Infant wide-field retinal image.
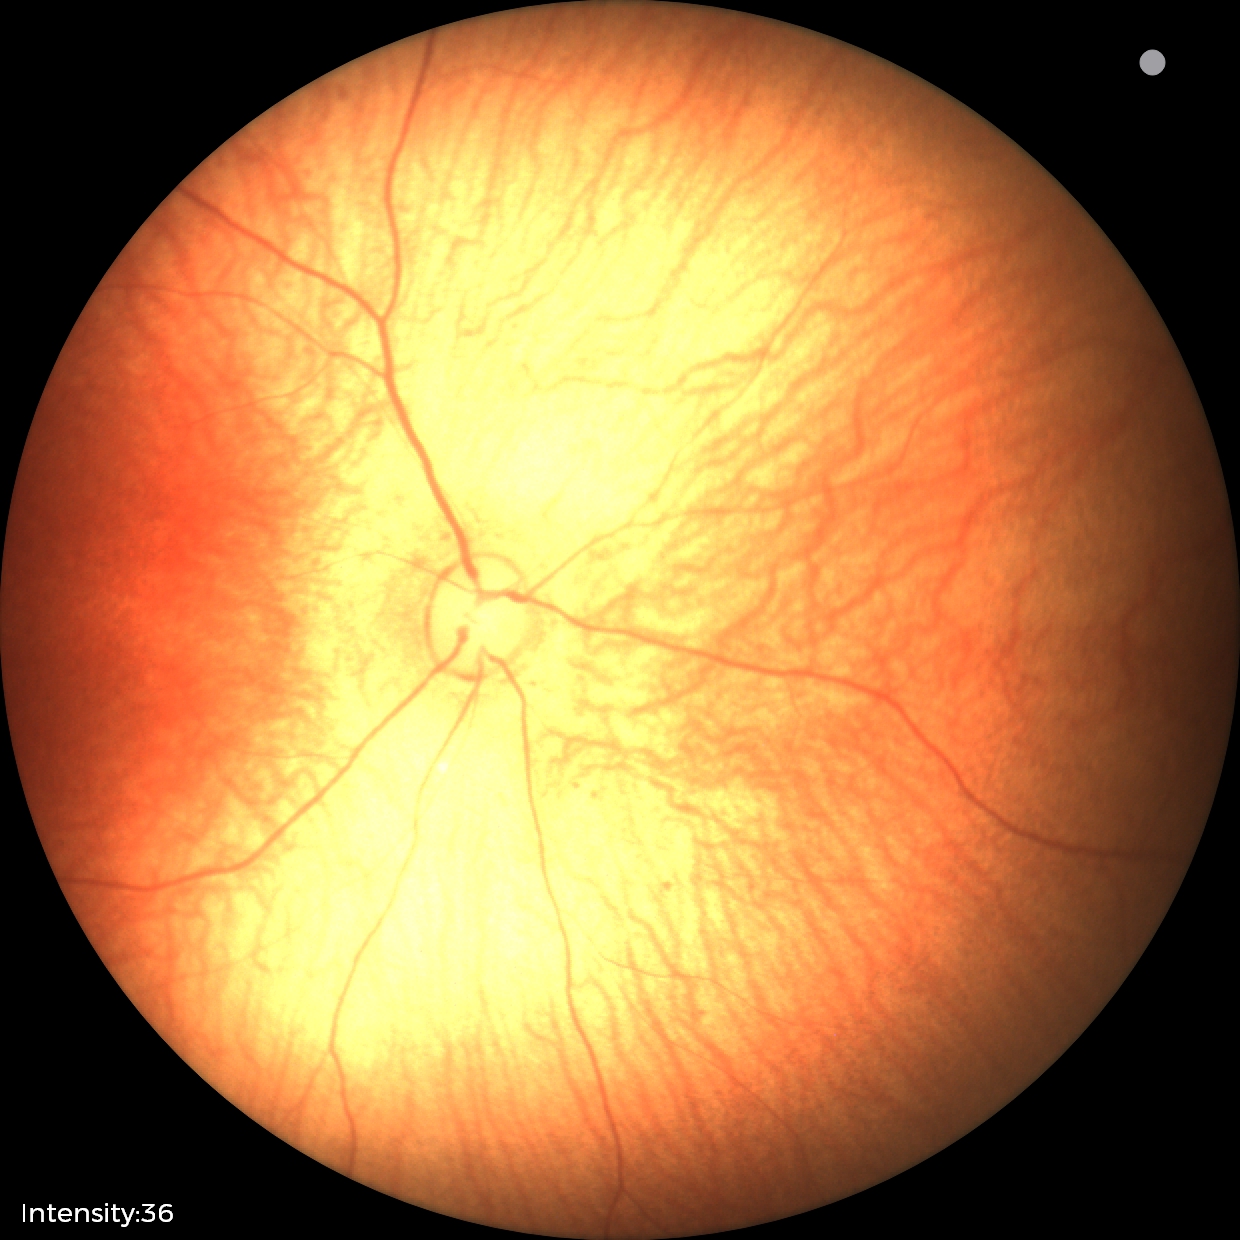

Screening diagnosis = normal